Modified Davis grading:
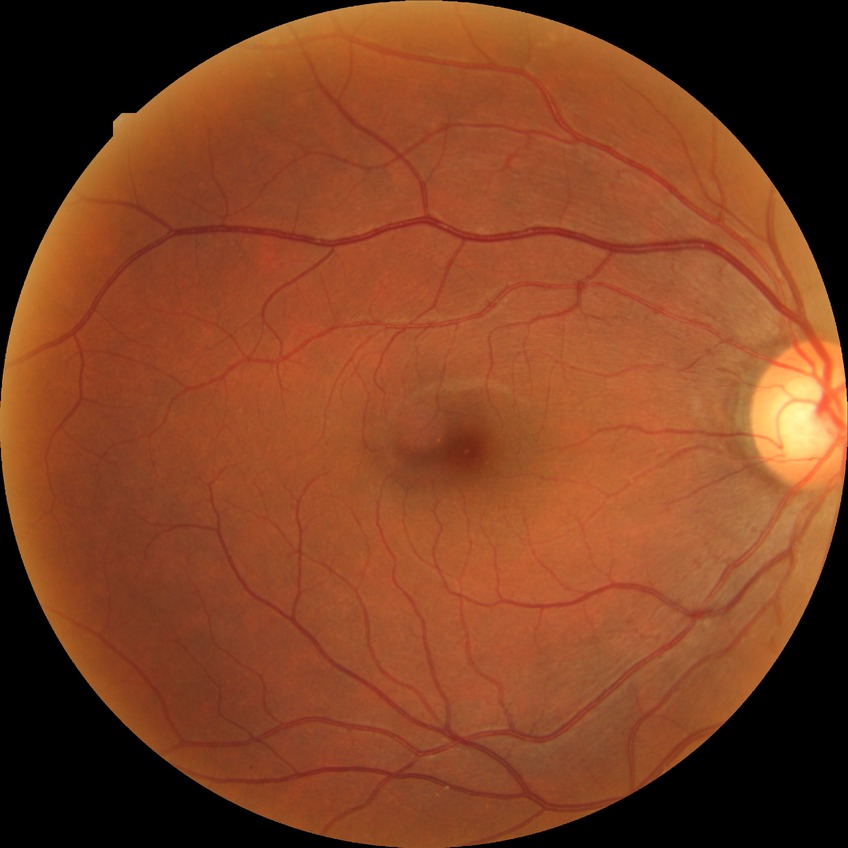
diabetic retinopathy (DR): no diabetic retinopathy (NDR).